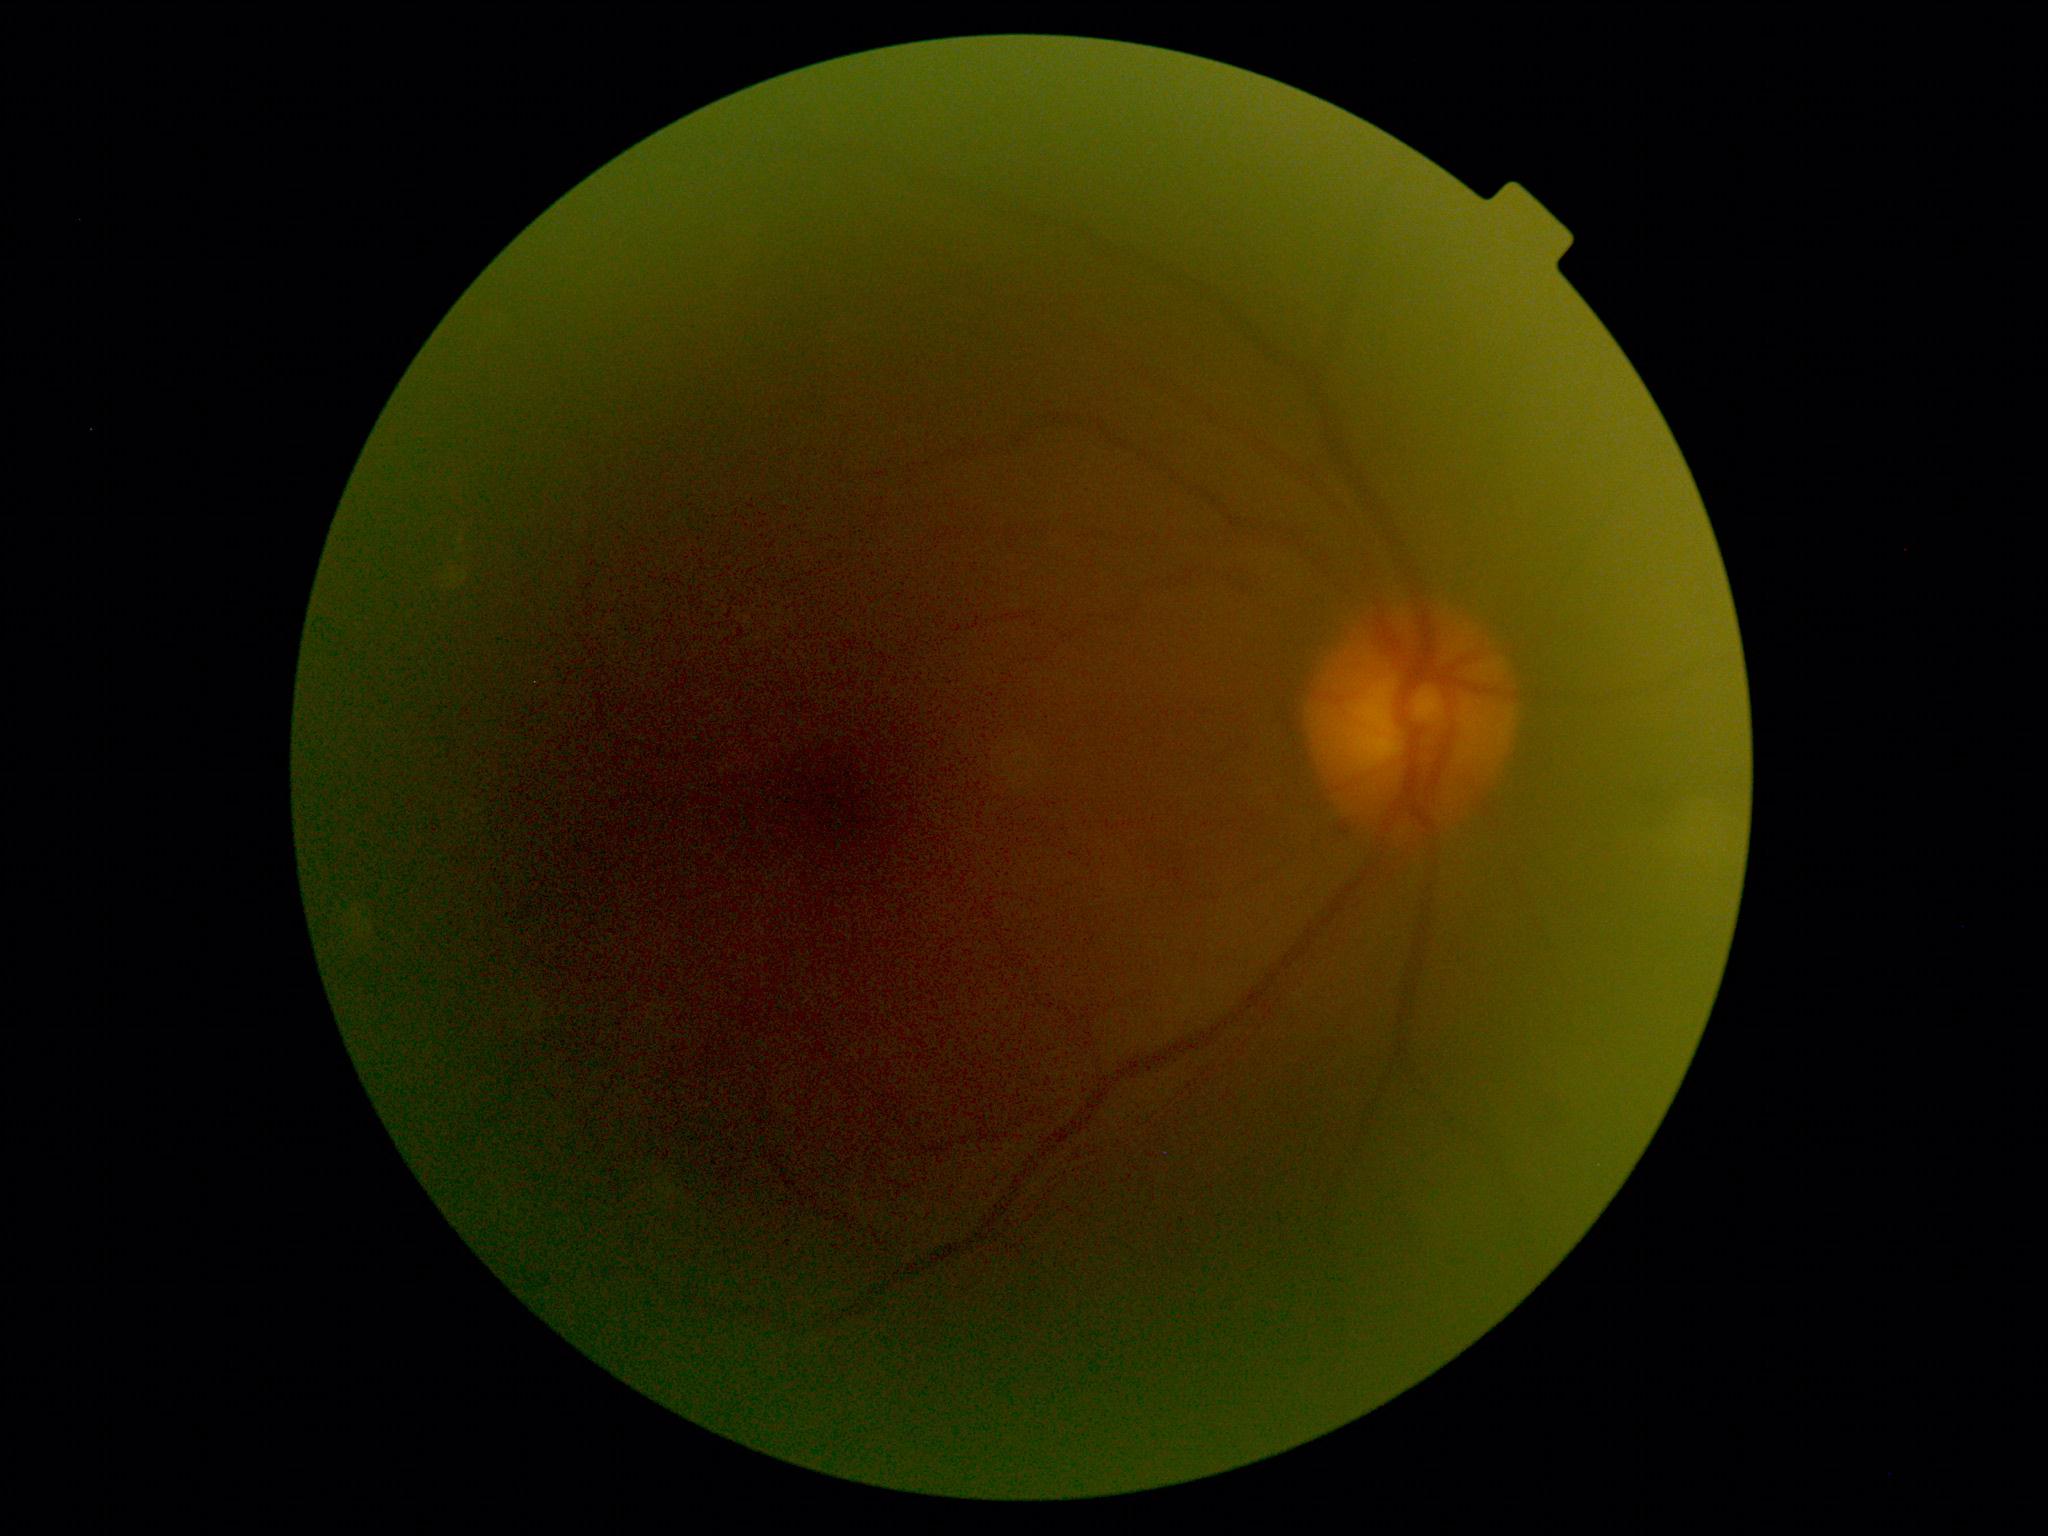
No diabetic retinal disease findings.
Diabetic retinopathy (DR): no apparent retinopathy (grade 0).